1525x1280:
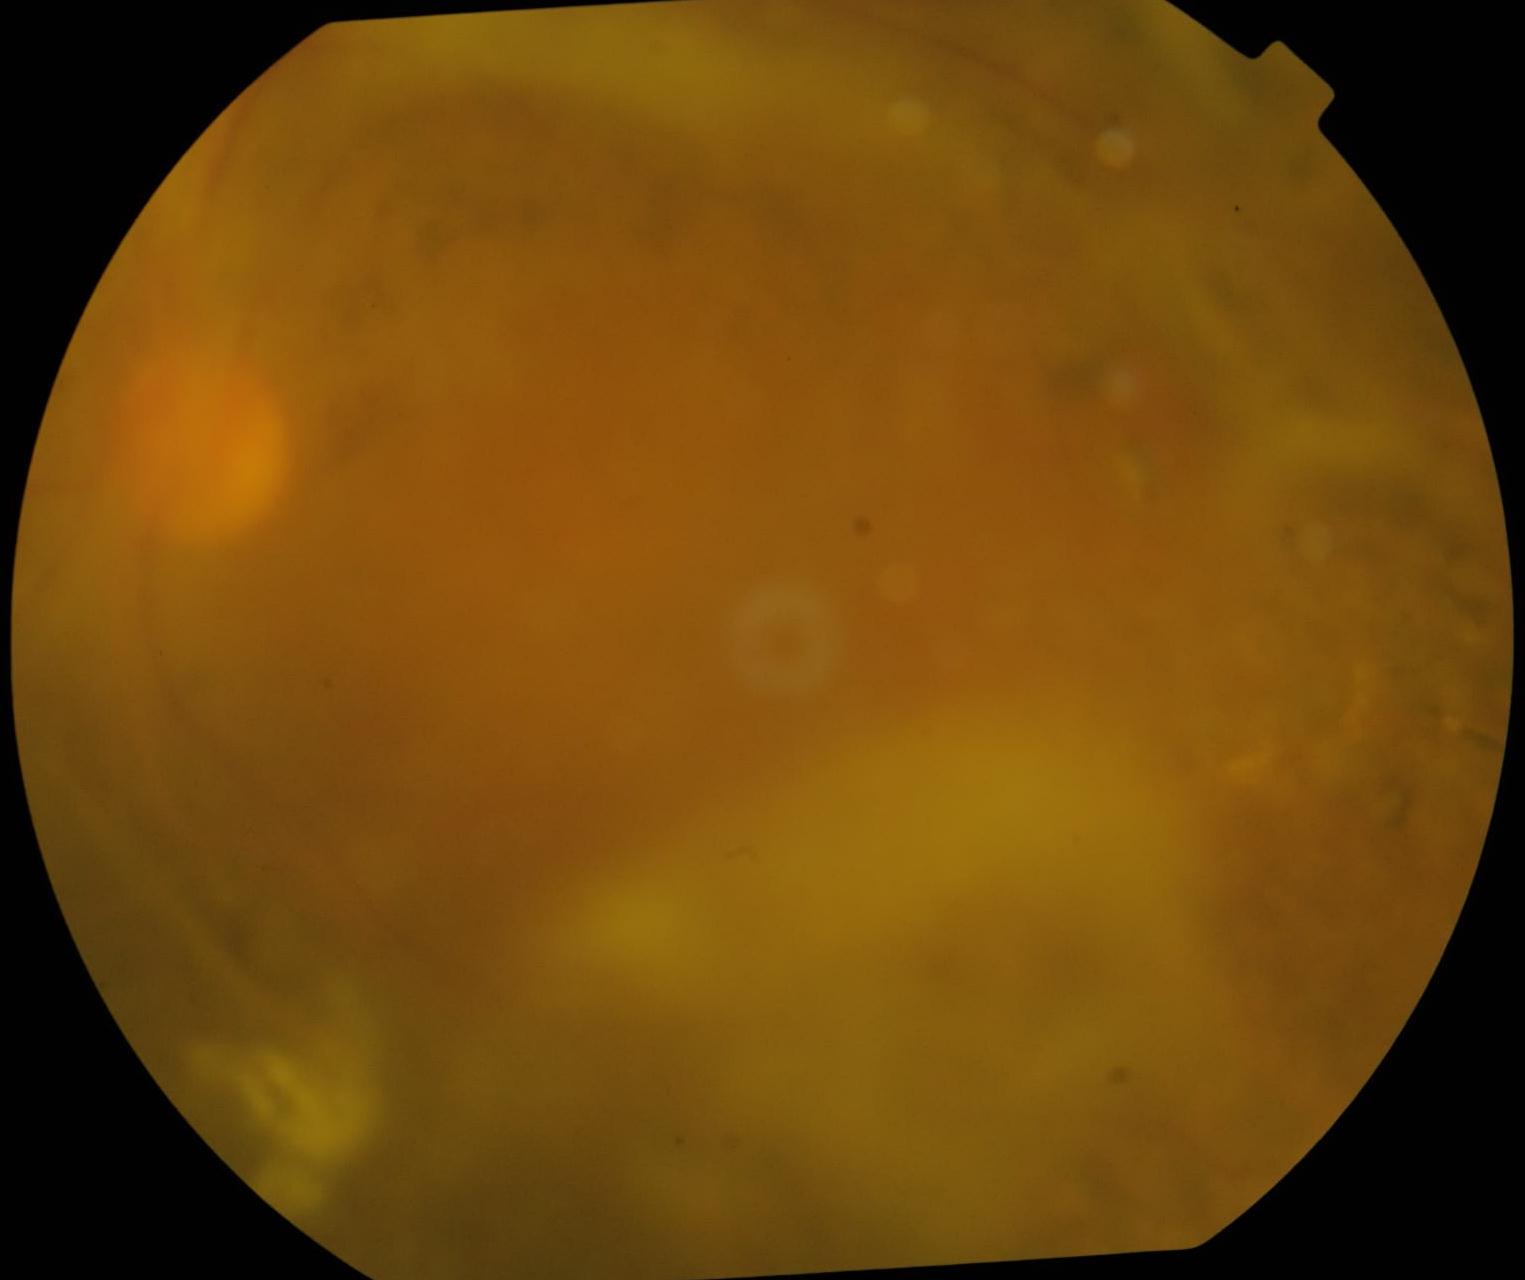

Diabetic retinopathy (DR): grade 4 (PDR).
The retinopathy is classified as proliferative diabetic retinopathy.